Posterior pole view, FOV: 50 degrees.
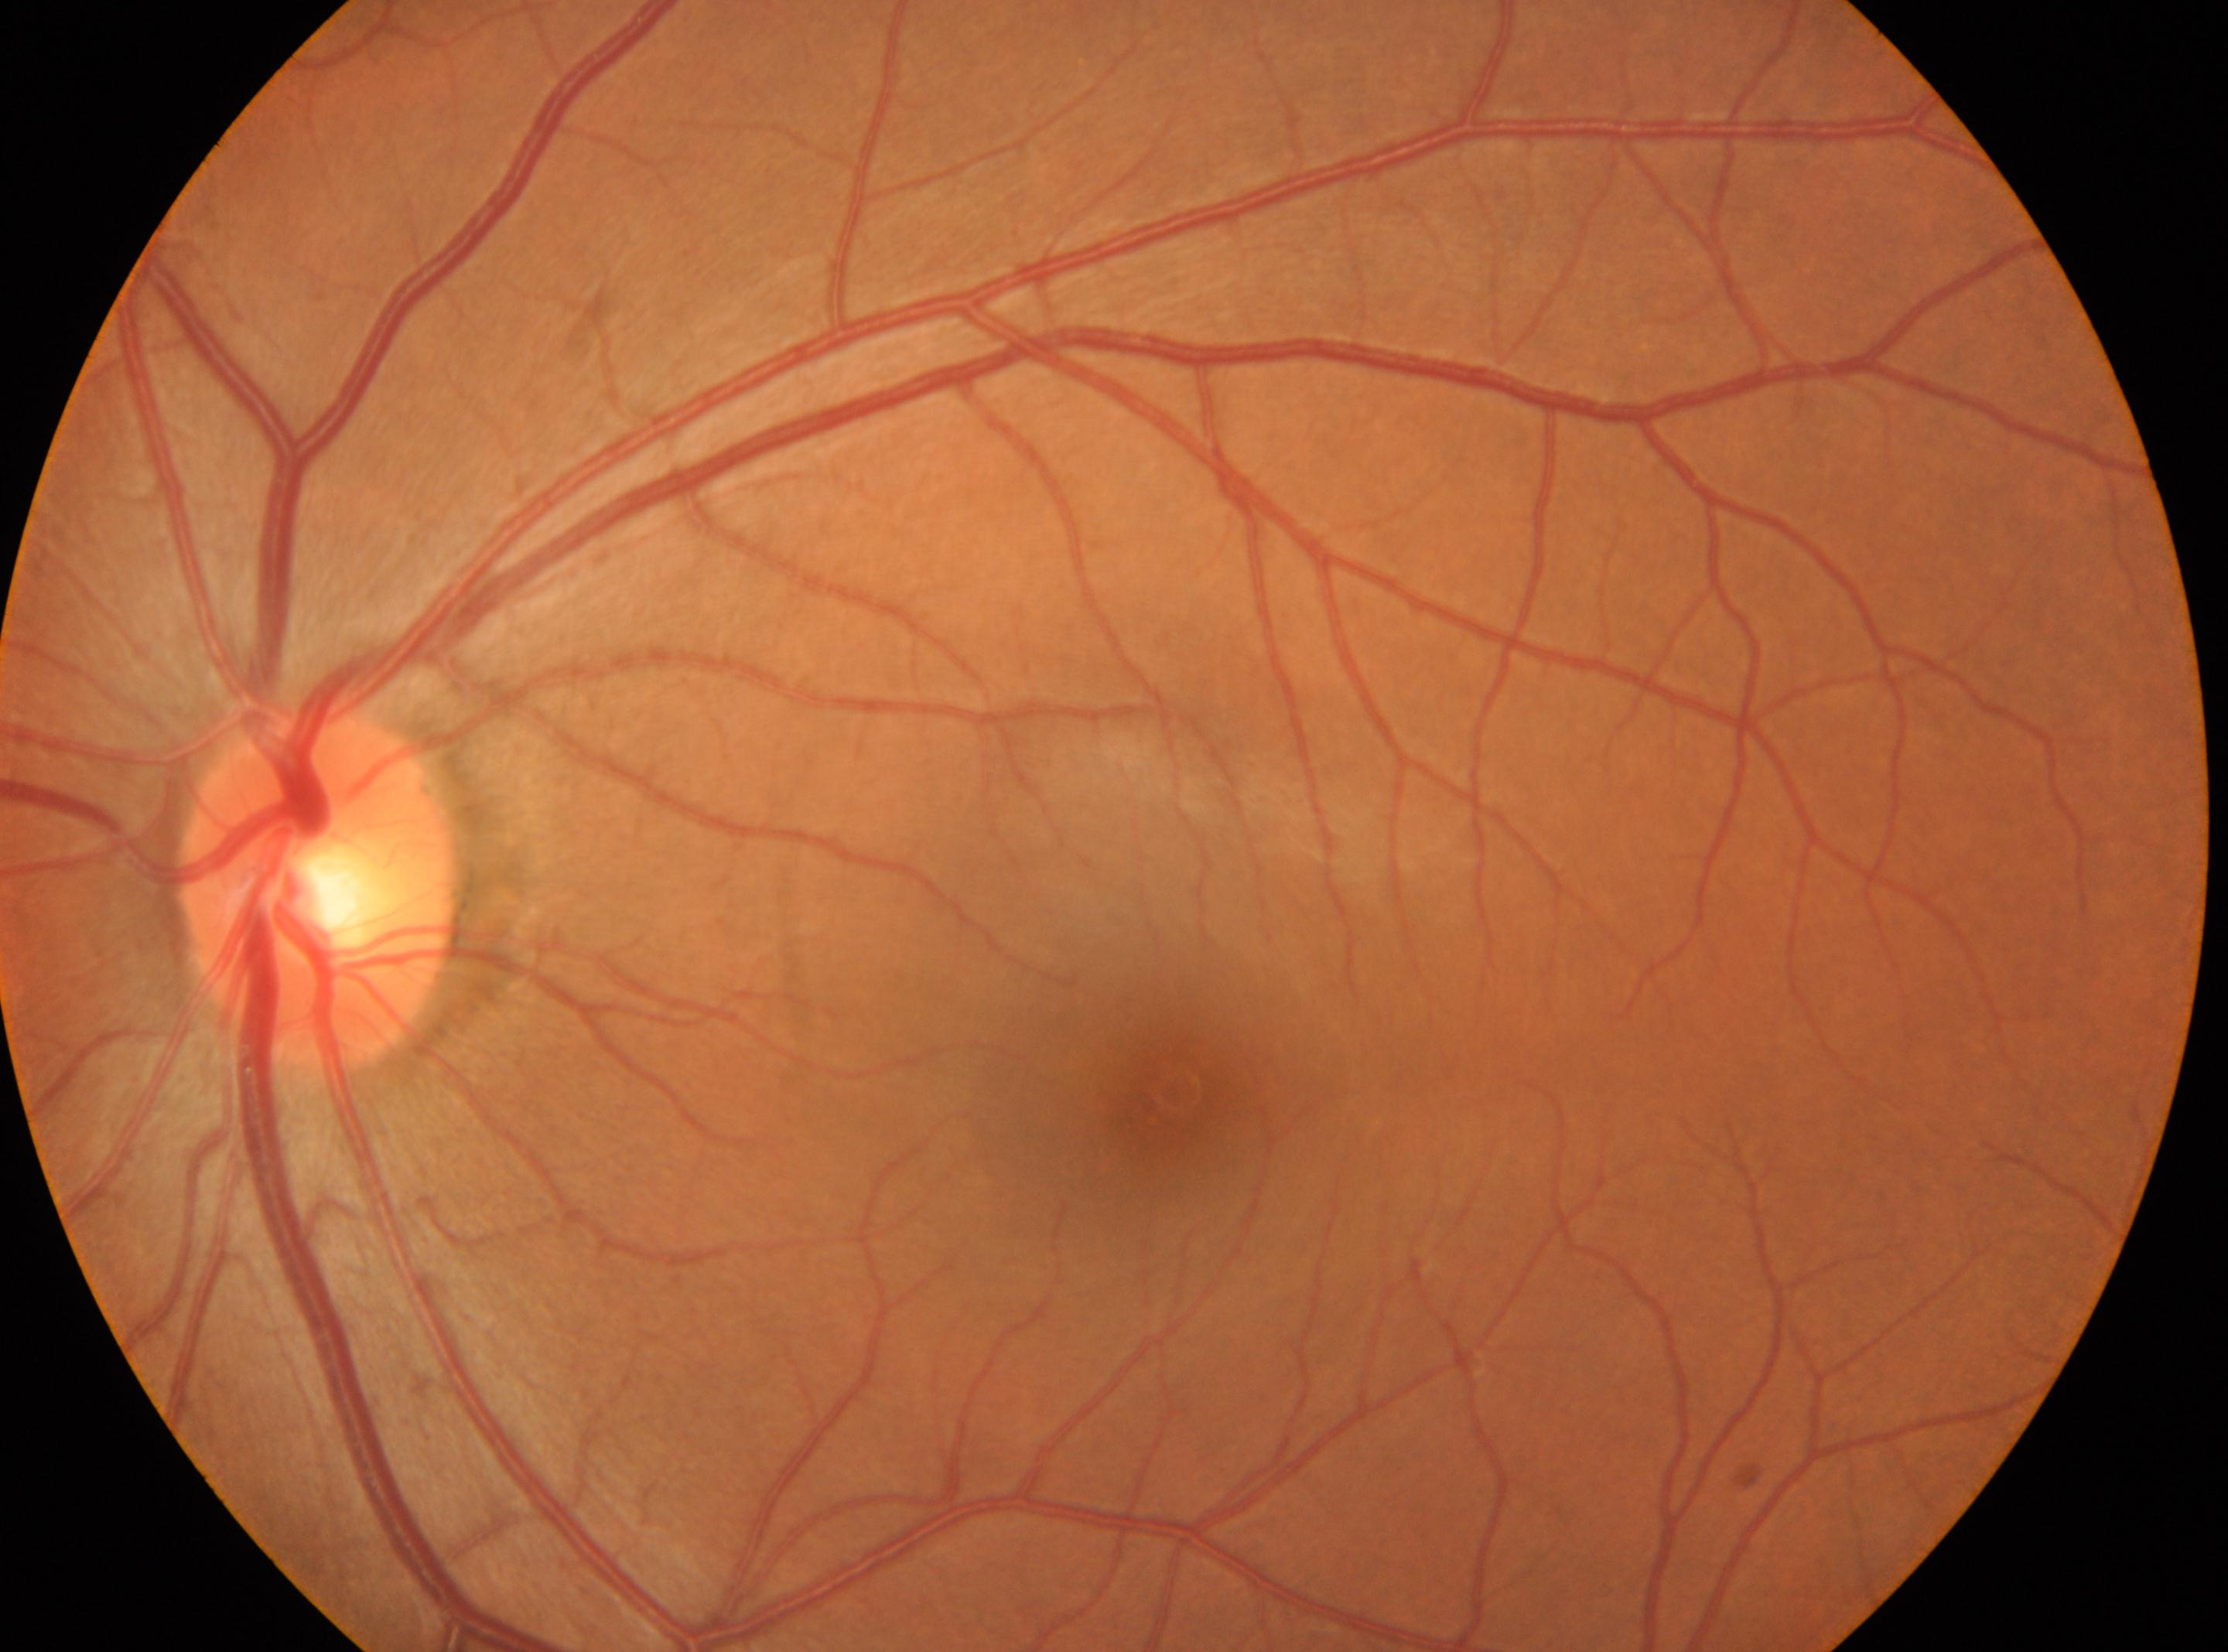 DR is 0. The fovea centralis is at x=1168, y=1092. No diabetic retinopathy identified. Optic disc center located at x=316, y=891. This is the oculus sinister.